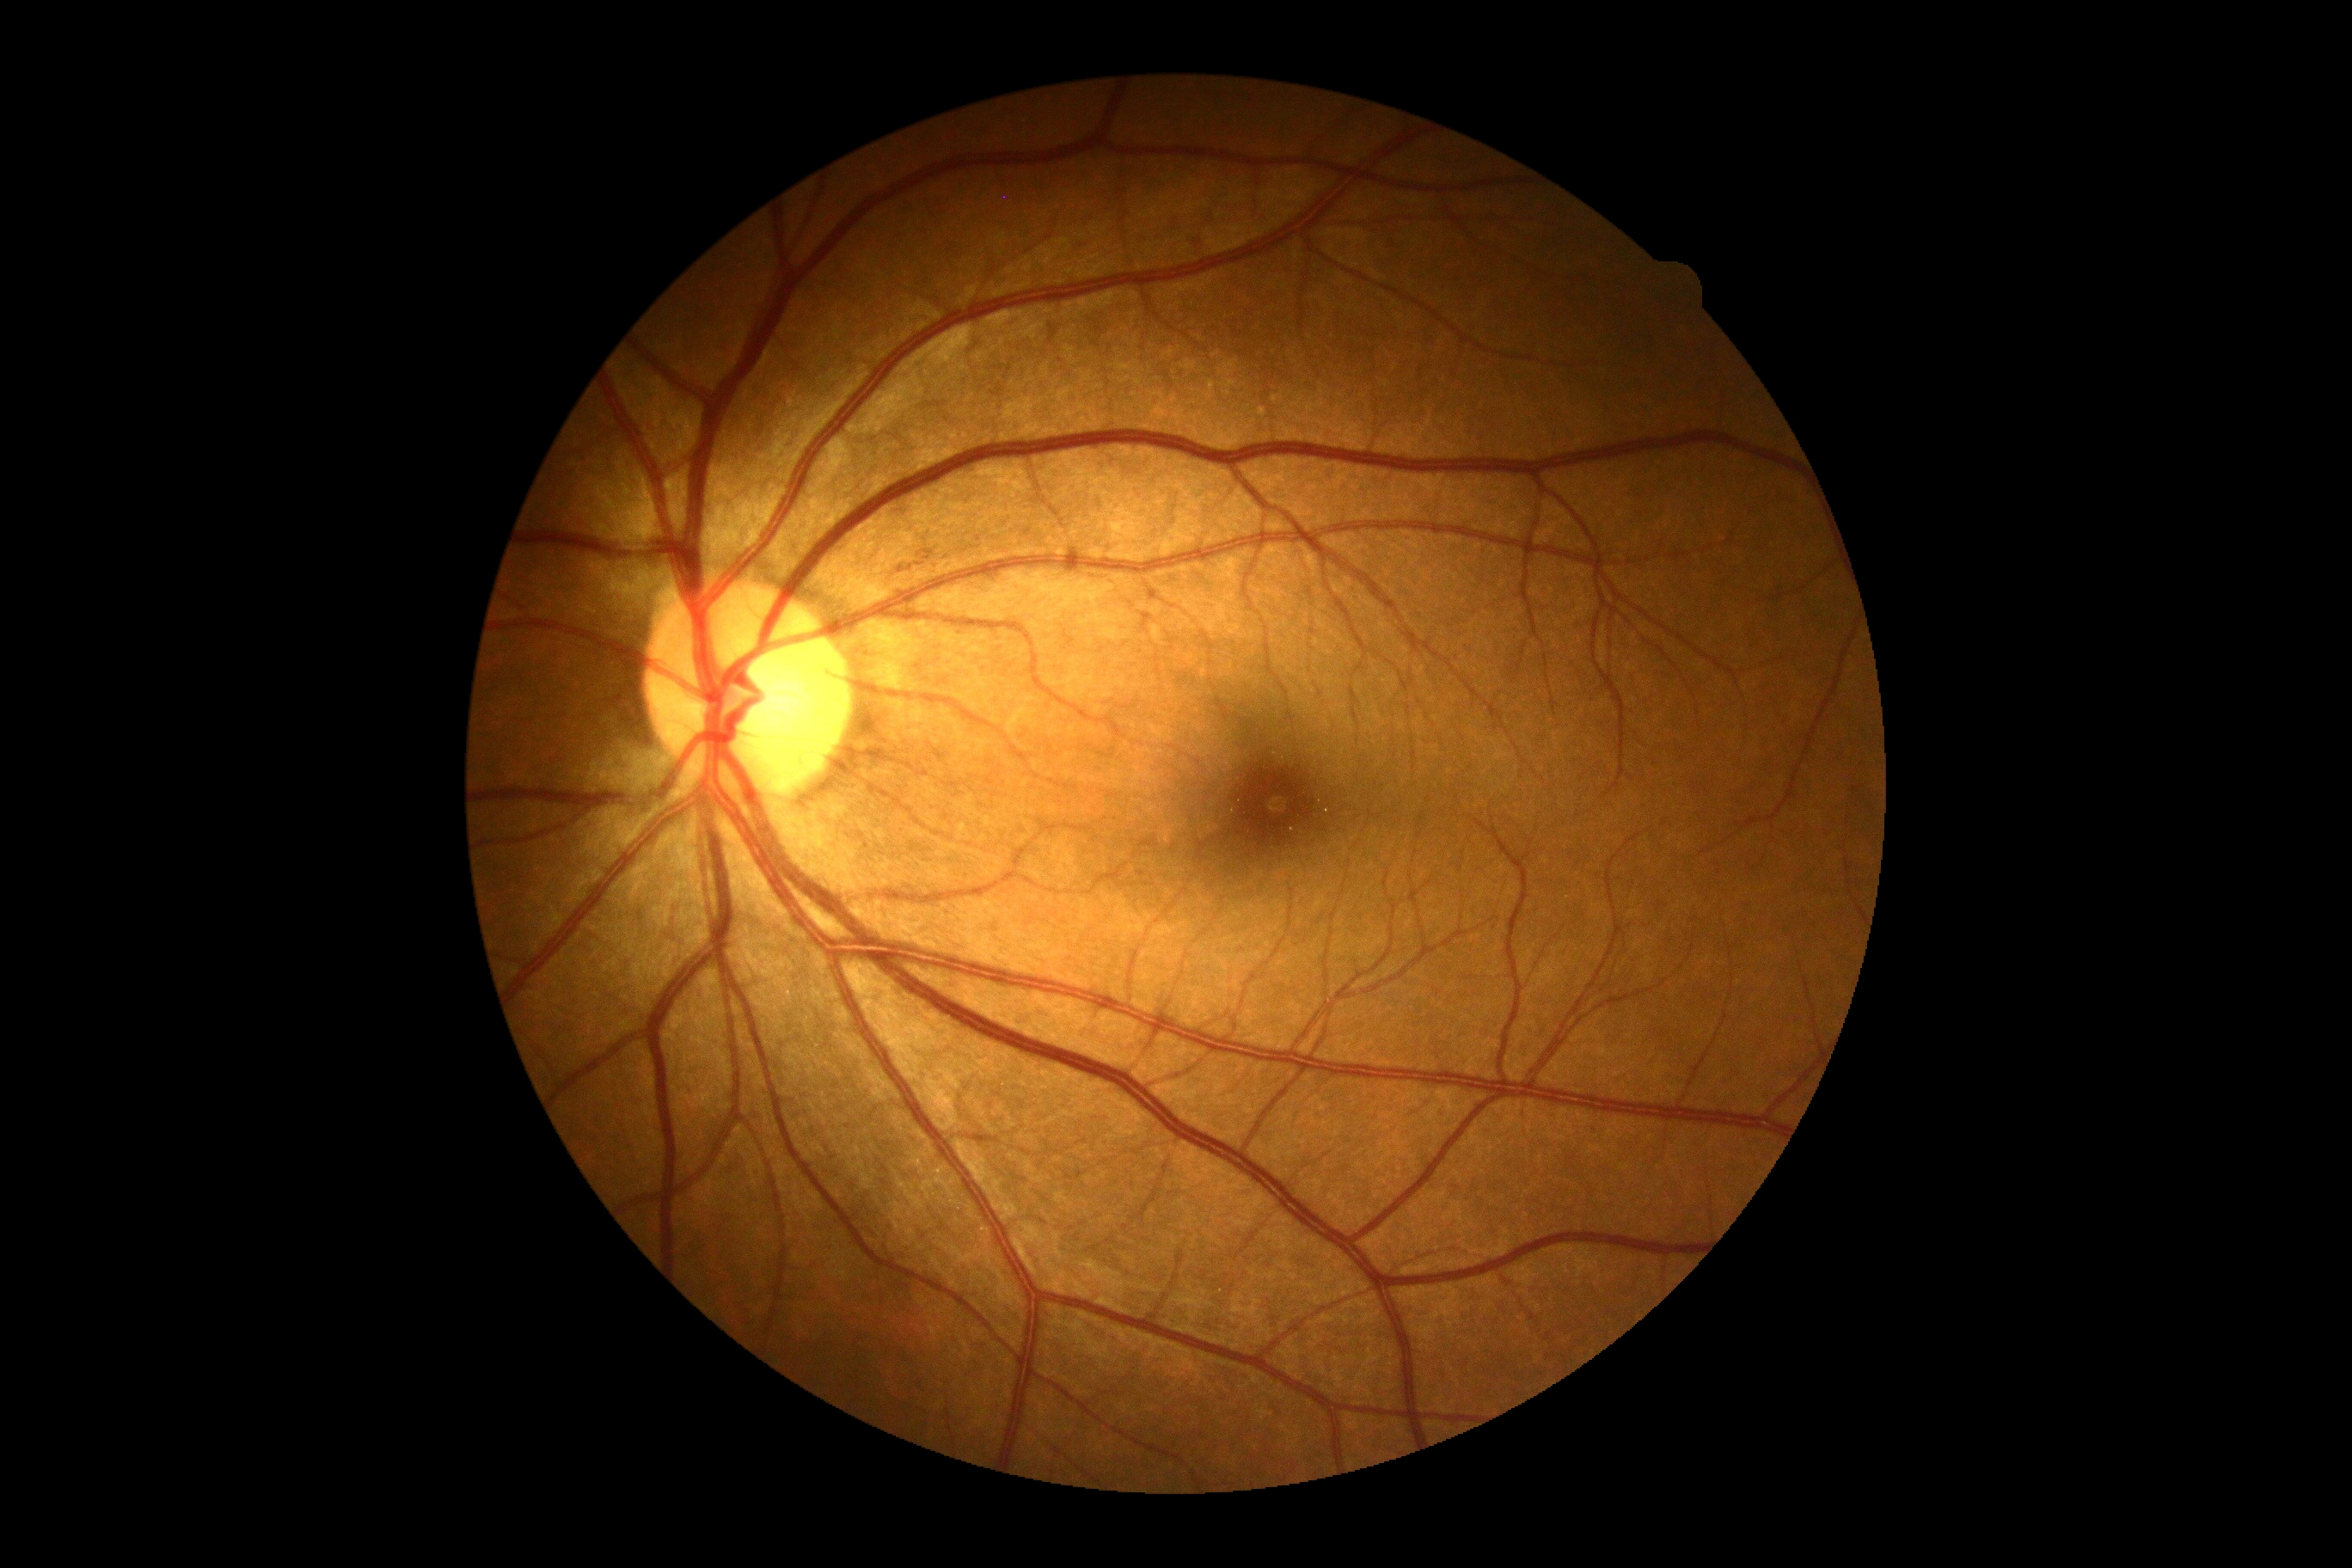 * DR grade: no apparent diabetic retinopathy (0) — no visible signs of diabetic retinopathy
* DR impression: no DR findings